45° field of view · 2352x1568 · fundus photo
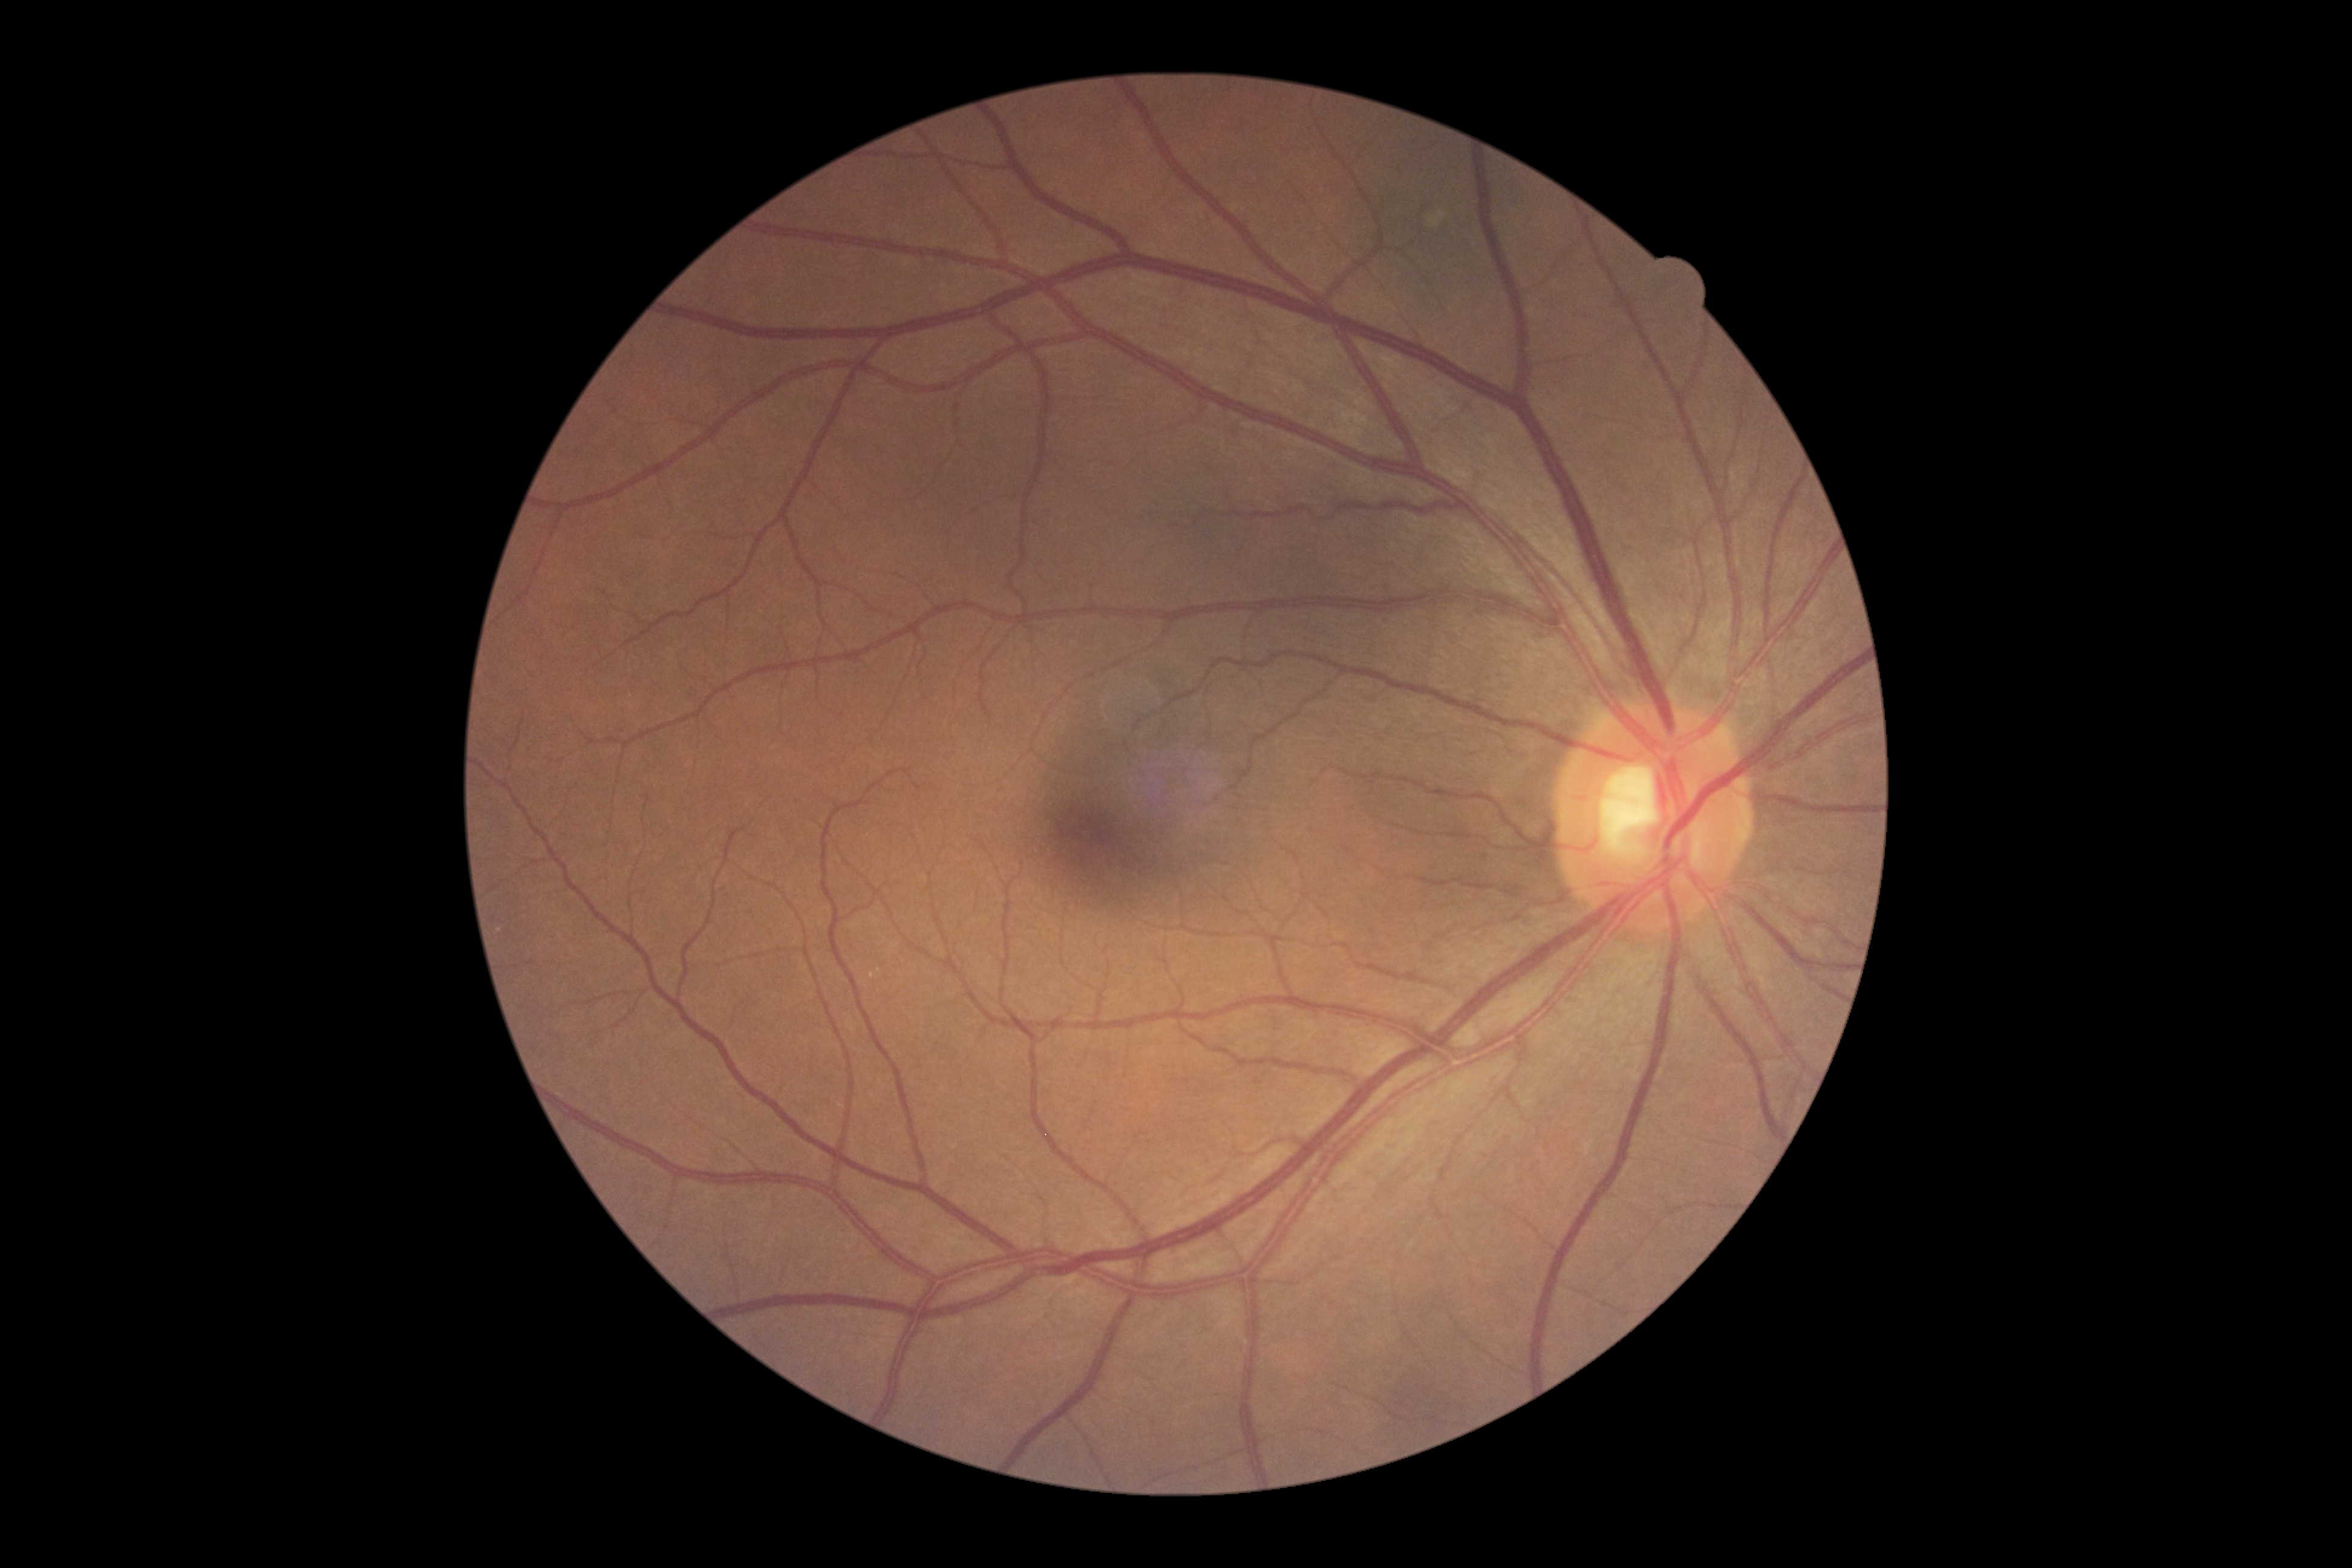

DR is no apparent retinopathy (grade 0).